Wide-field fundus image from infant ROP screening:
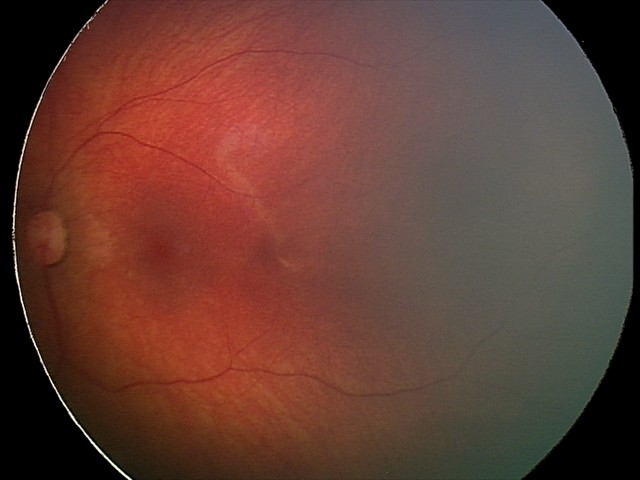 Screening: retinal hemorrhages.